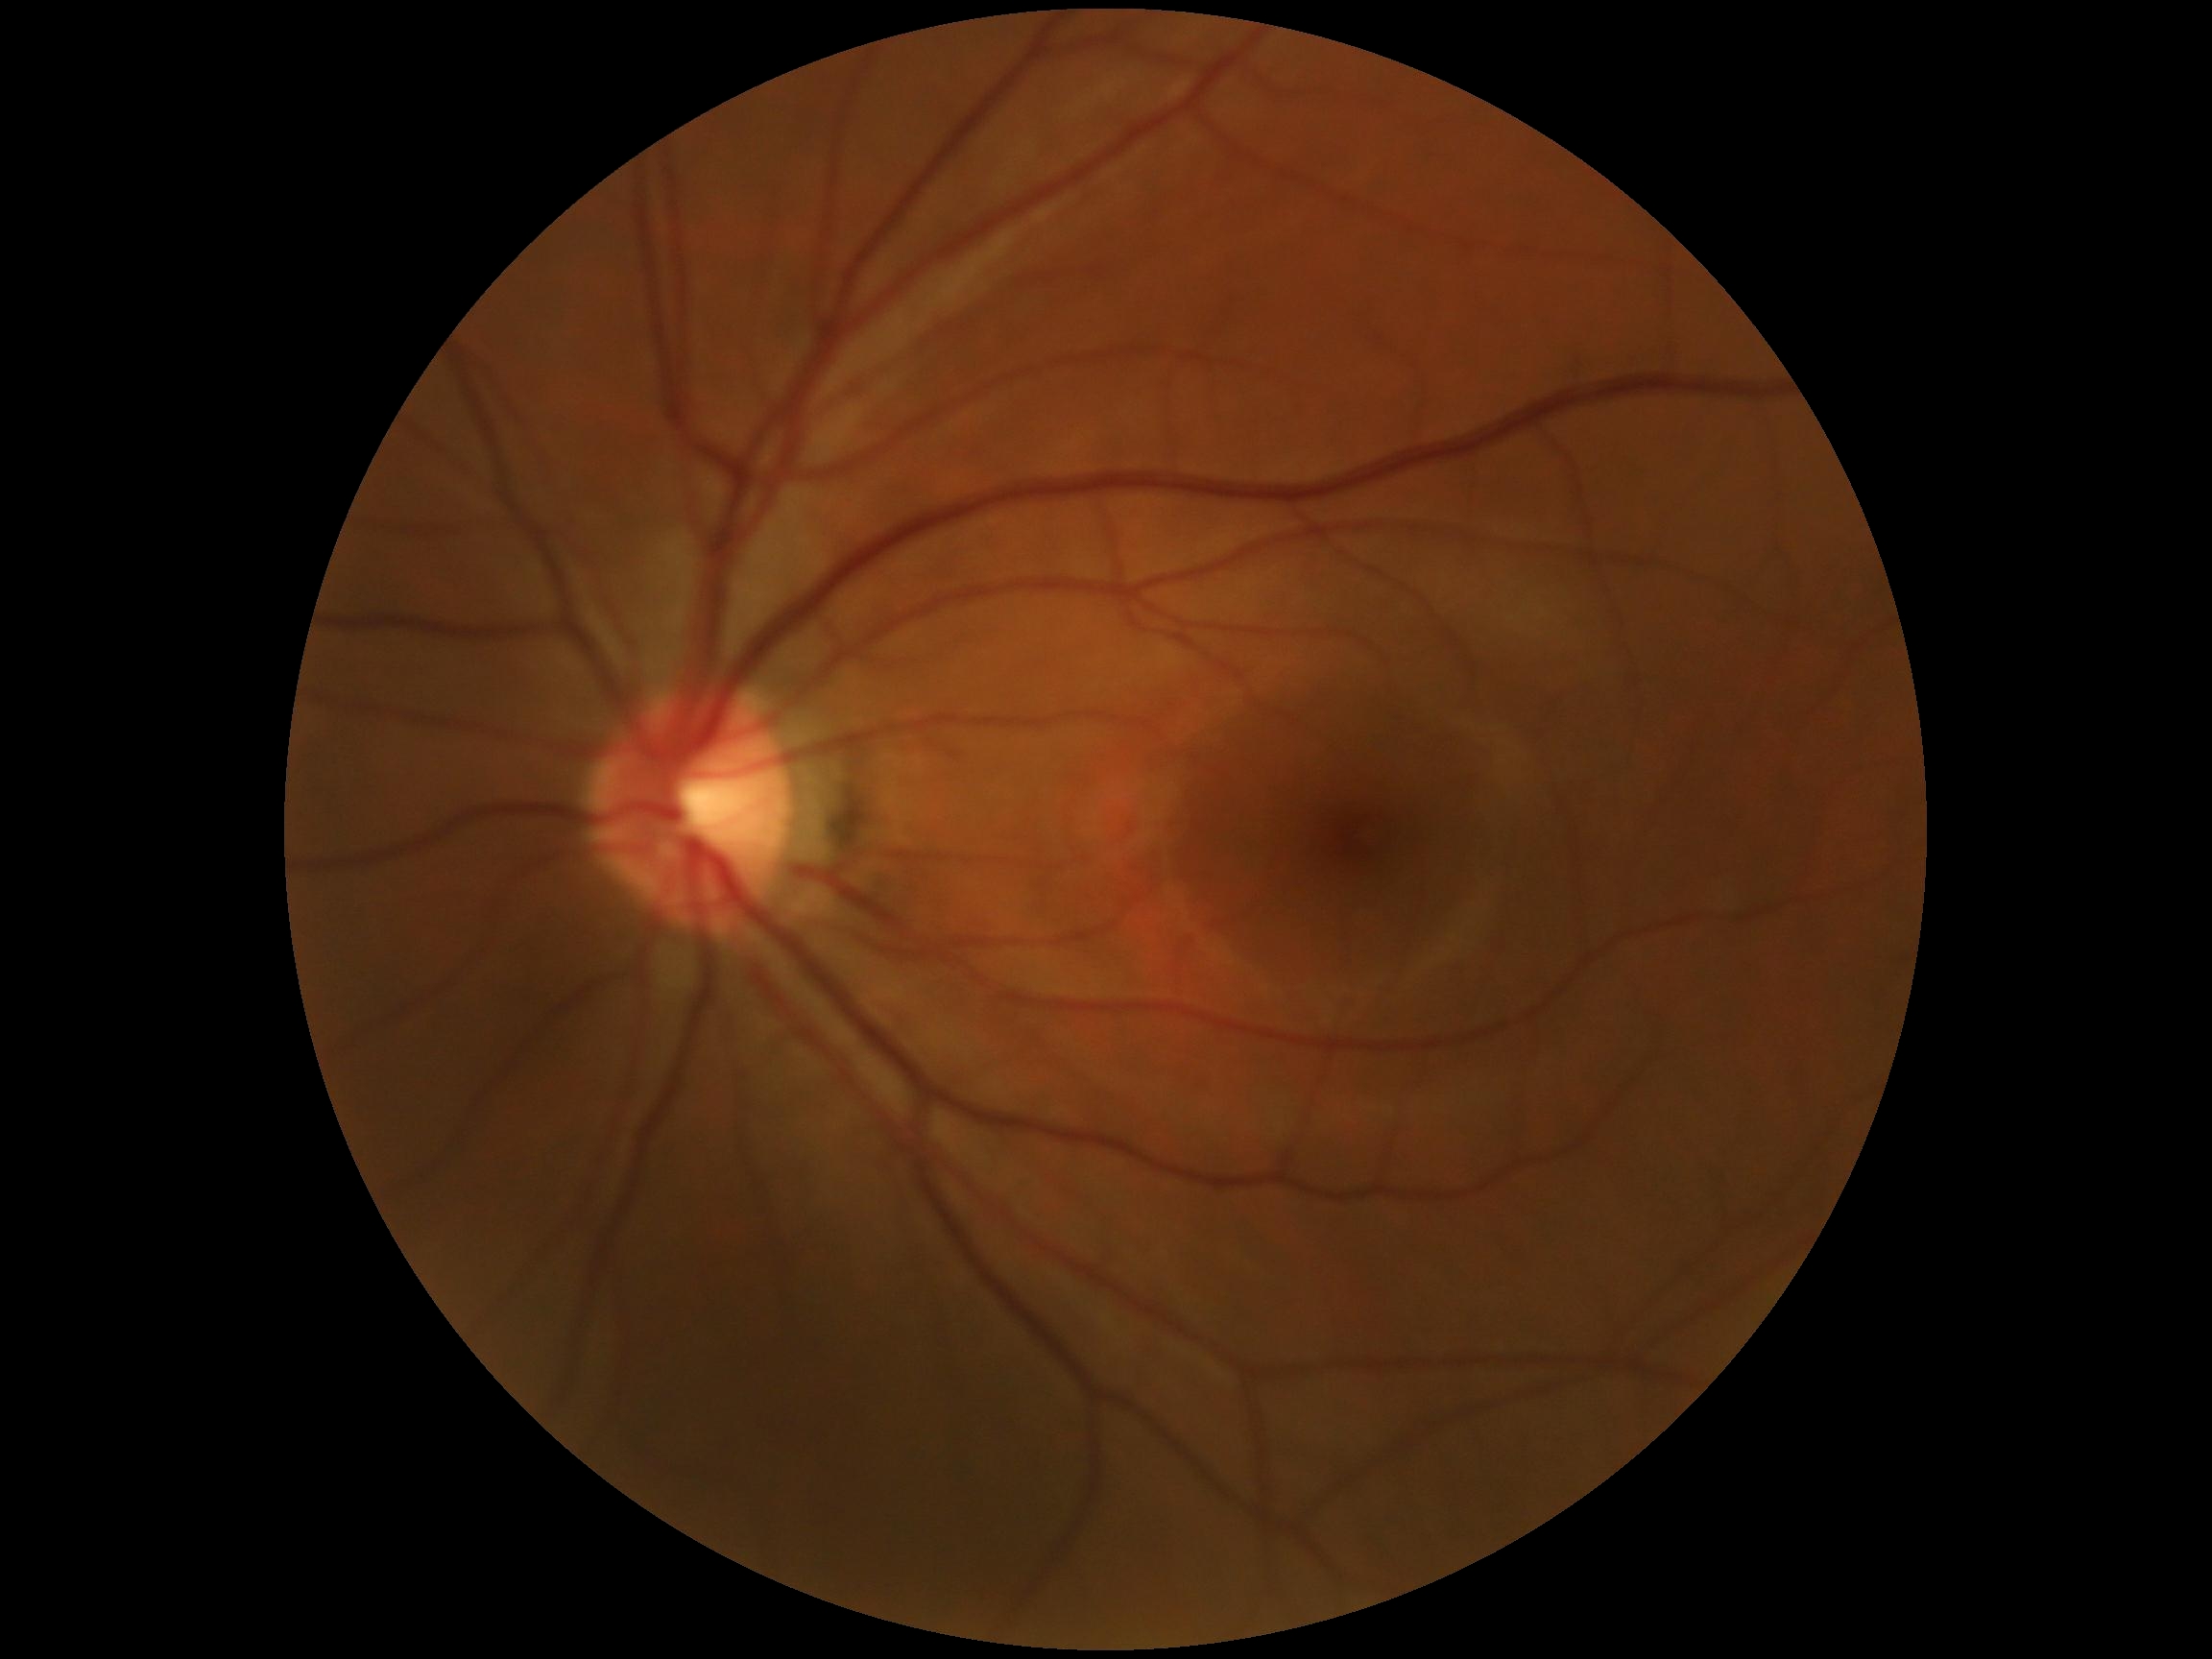
Diabetic retinopathy (DR) is 0.